Wide-field fundus photograph from neonatal ROP screening
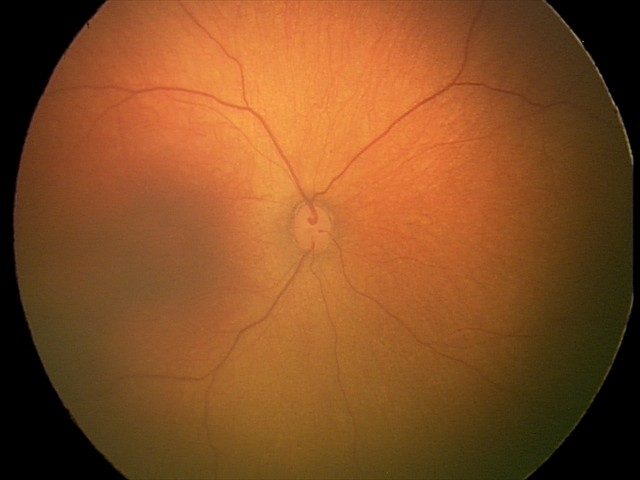

Assessment = physiological